Without pupil dilation. 45 degree fundus photograph:
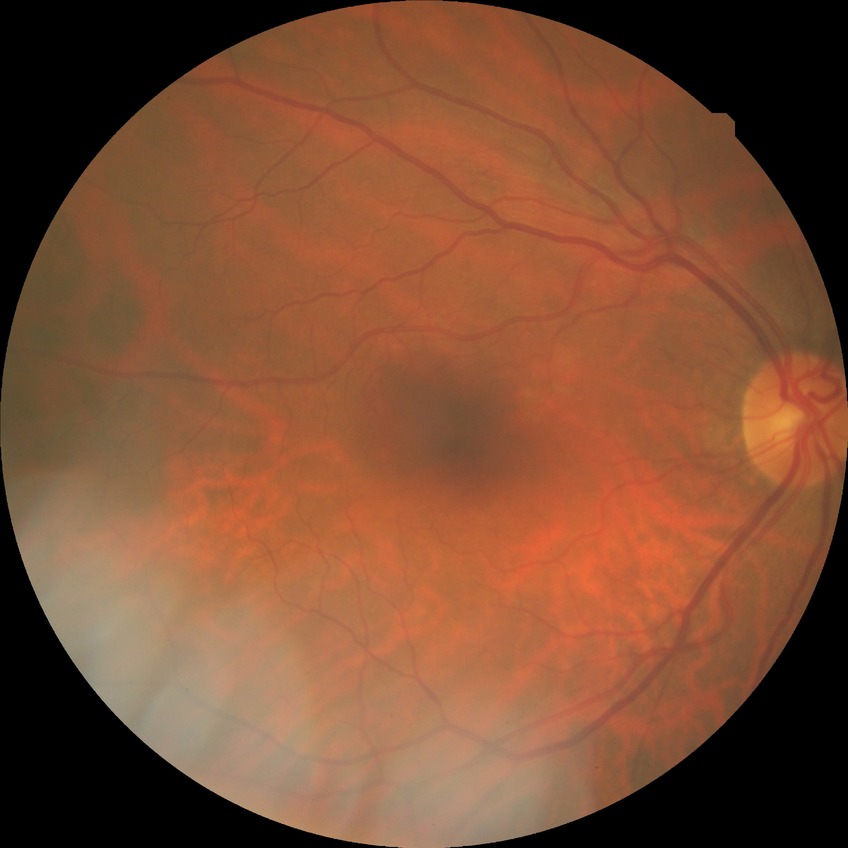 - diabetic retinopathy (DR): no diabetic retinopathy (NDR)